Pupil-dilated, 50-degree field of view
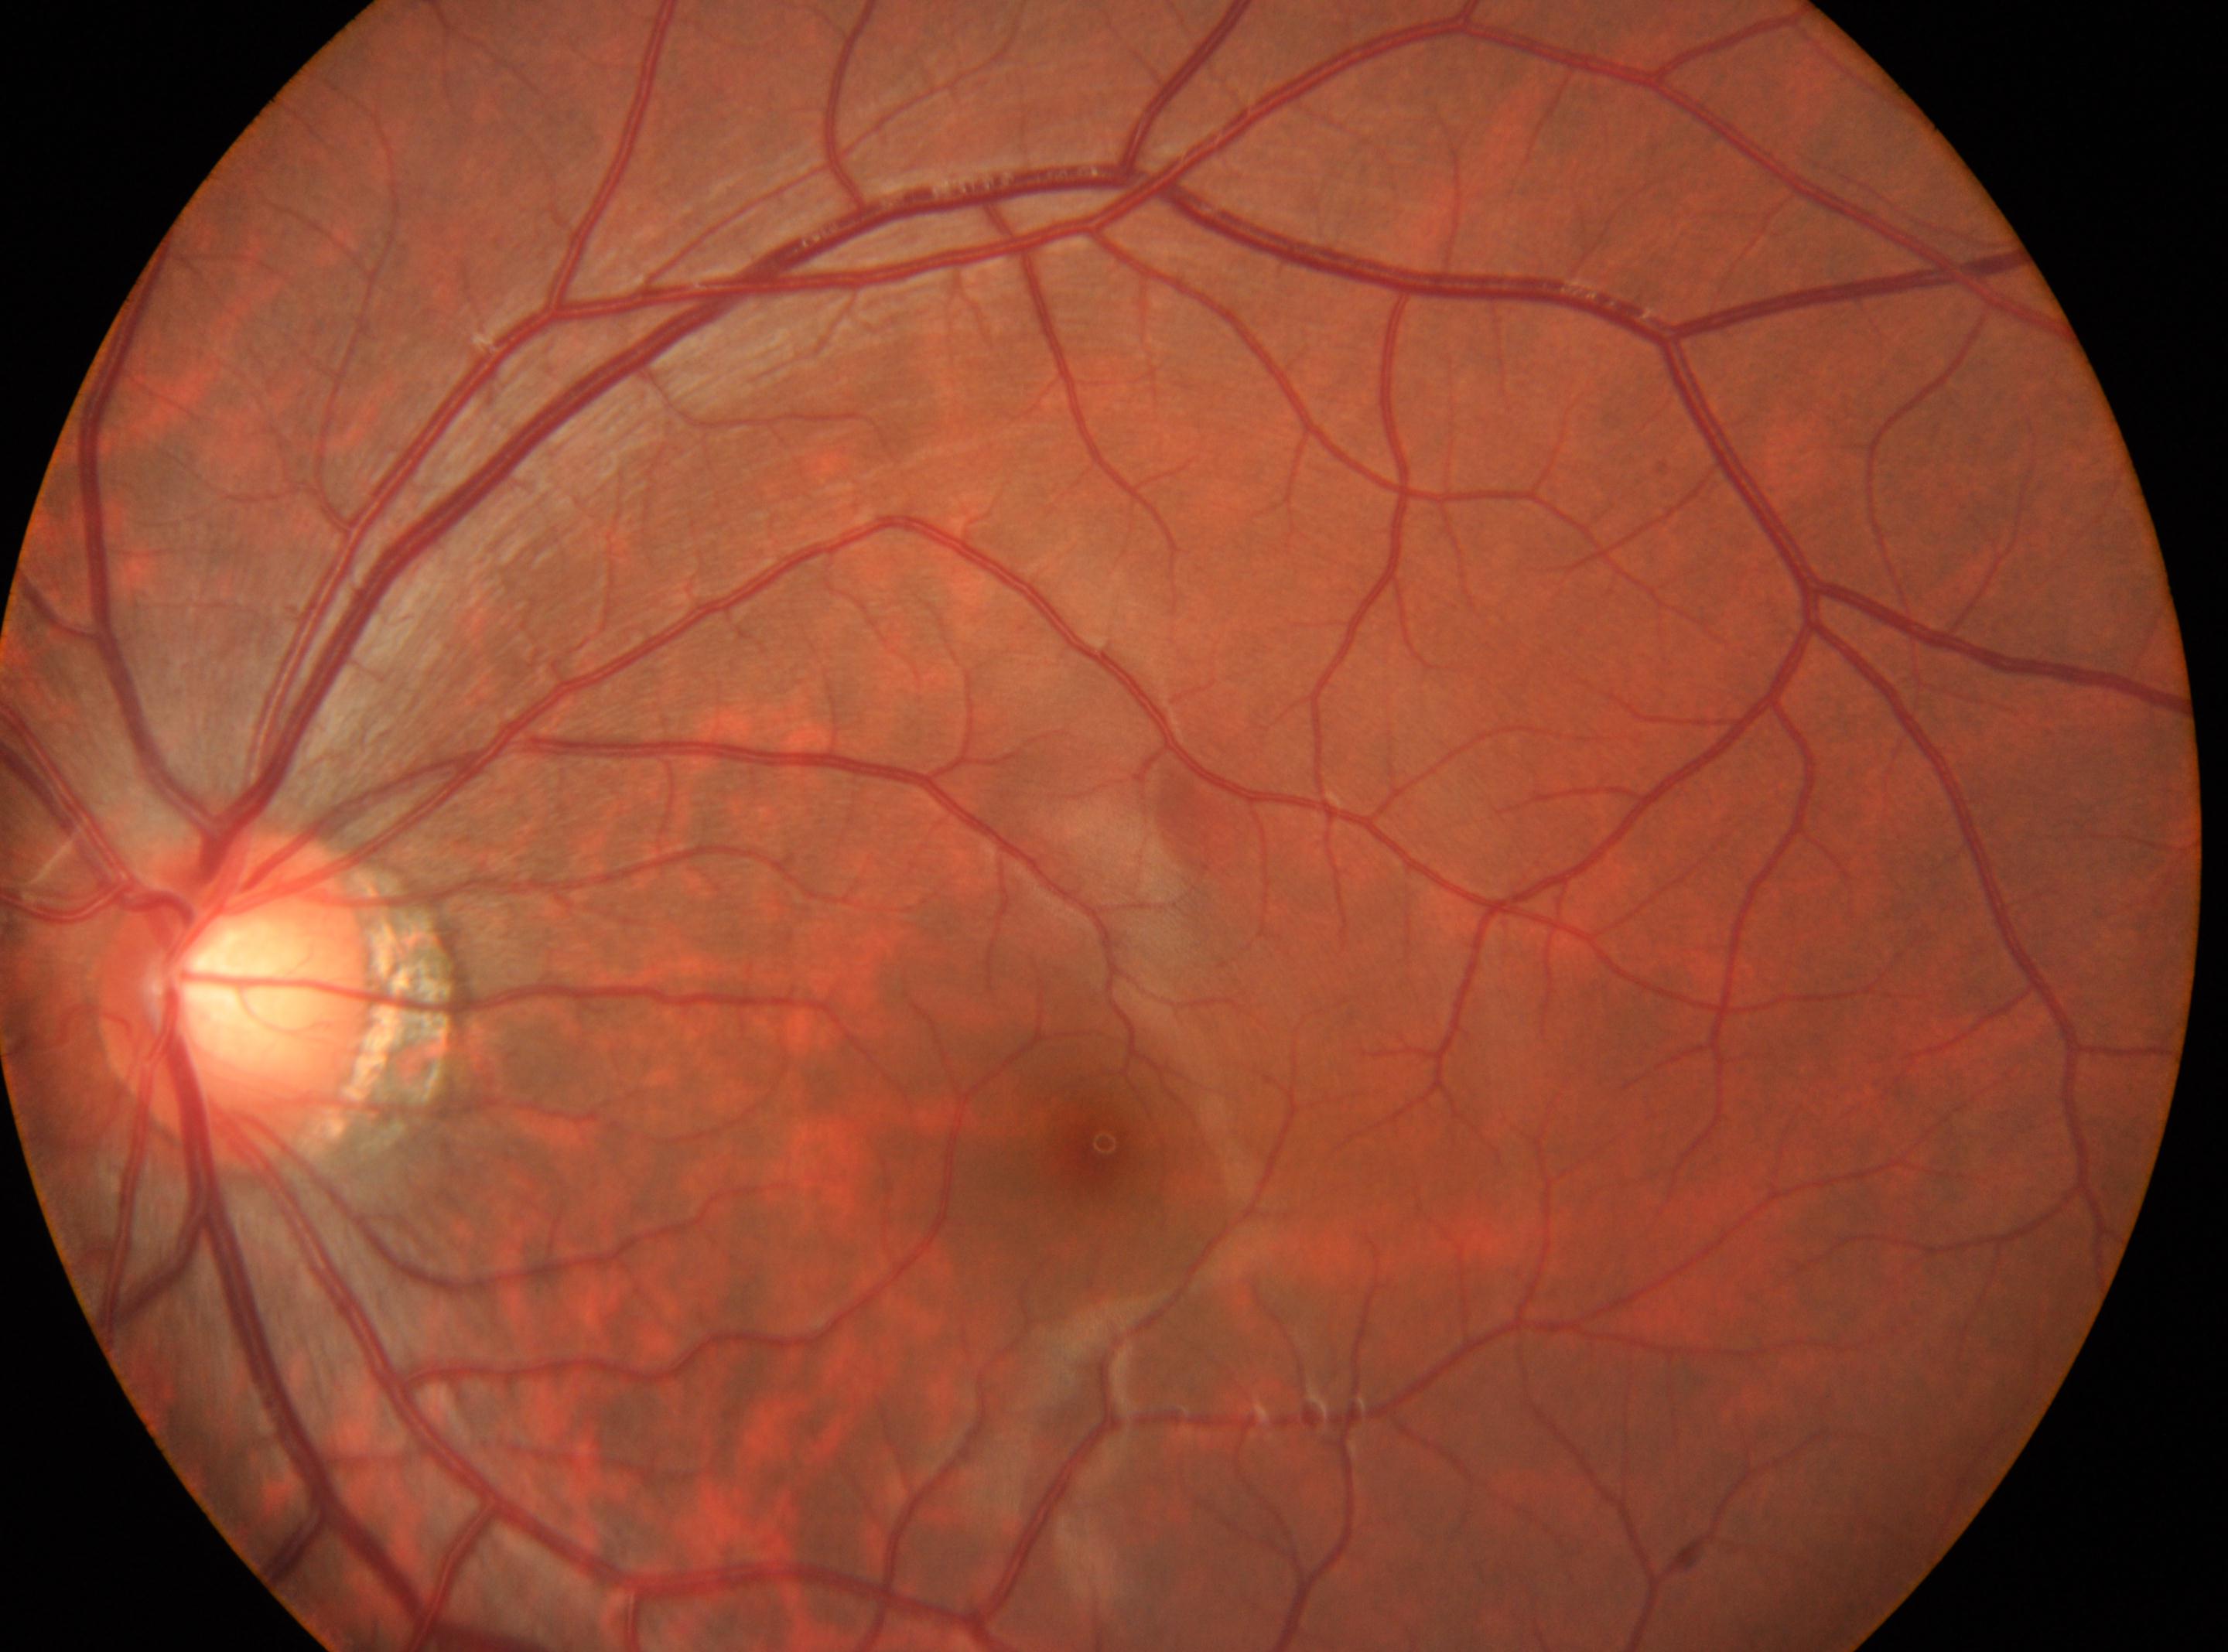
the fovea@[1103, 1142] | the optic disc@[235, 997] | diabetic retinopathy@0 | left | No signs of diabetic retinopathy.